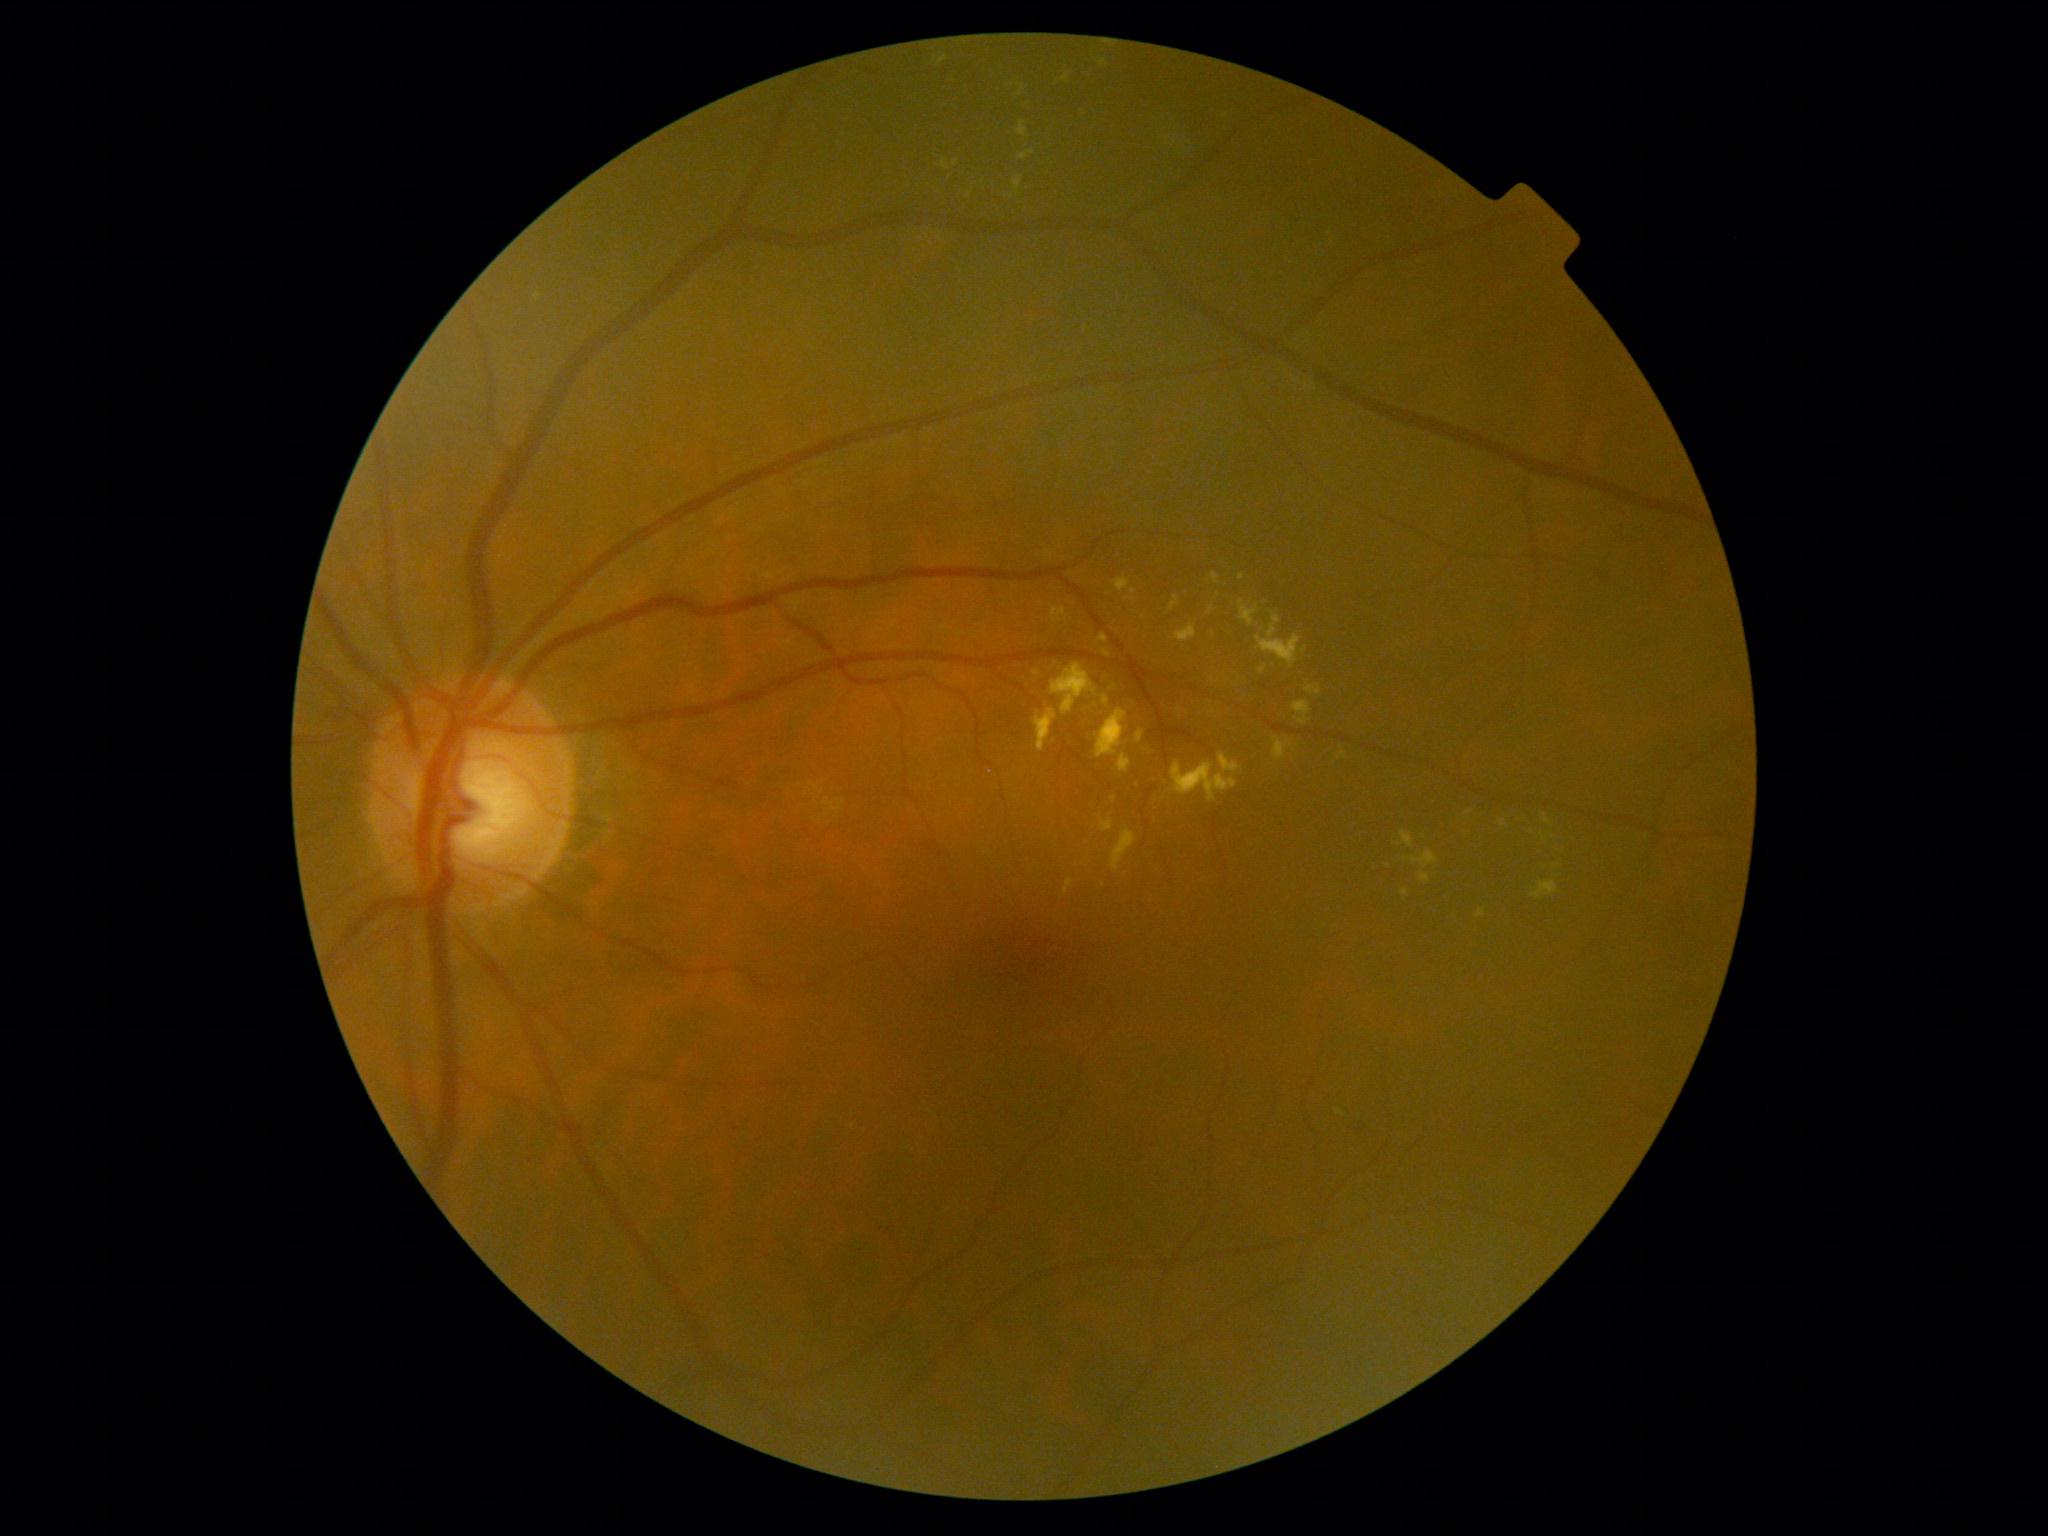

partial: true
dr_grade: 2
lesions:
  ex:
    - box=[1218, 753, 1242, 773]
    - box=[1476, 909, 1486, 920]
    - box=[1033, 710, 1057, 753]
    - box=[1259, 666, 1268, 674]
    - box=[1099, 634, 1109, 644]
    - box=[1051, 663, 1097, 716]
    - box=[1011, 83, 1025, 98]
    - box=[1064, 879, 1074, 897]
    - box=[1211, 574, 1219, 585]
    - box=[1117, 755, 1132, 773]
    - box=[1208, 607, 1215, 615]
  ex_small_centers:
    - (x=1242, y=578)
    - (x=854, y=1127)
    - (x=1557, y=866)
    - (x=1037, y=673)